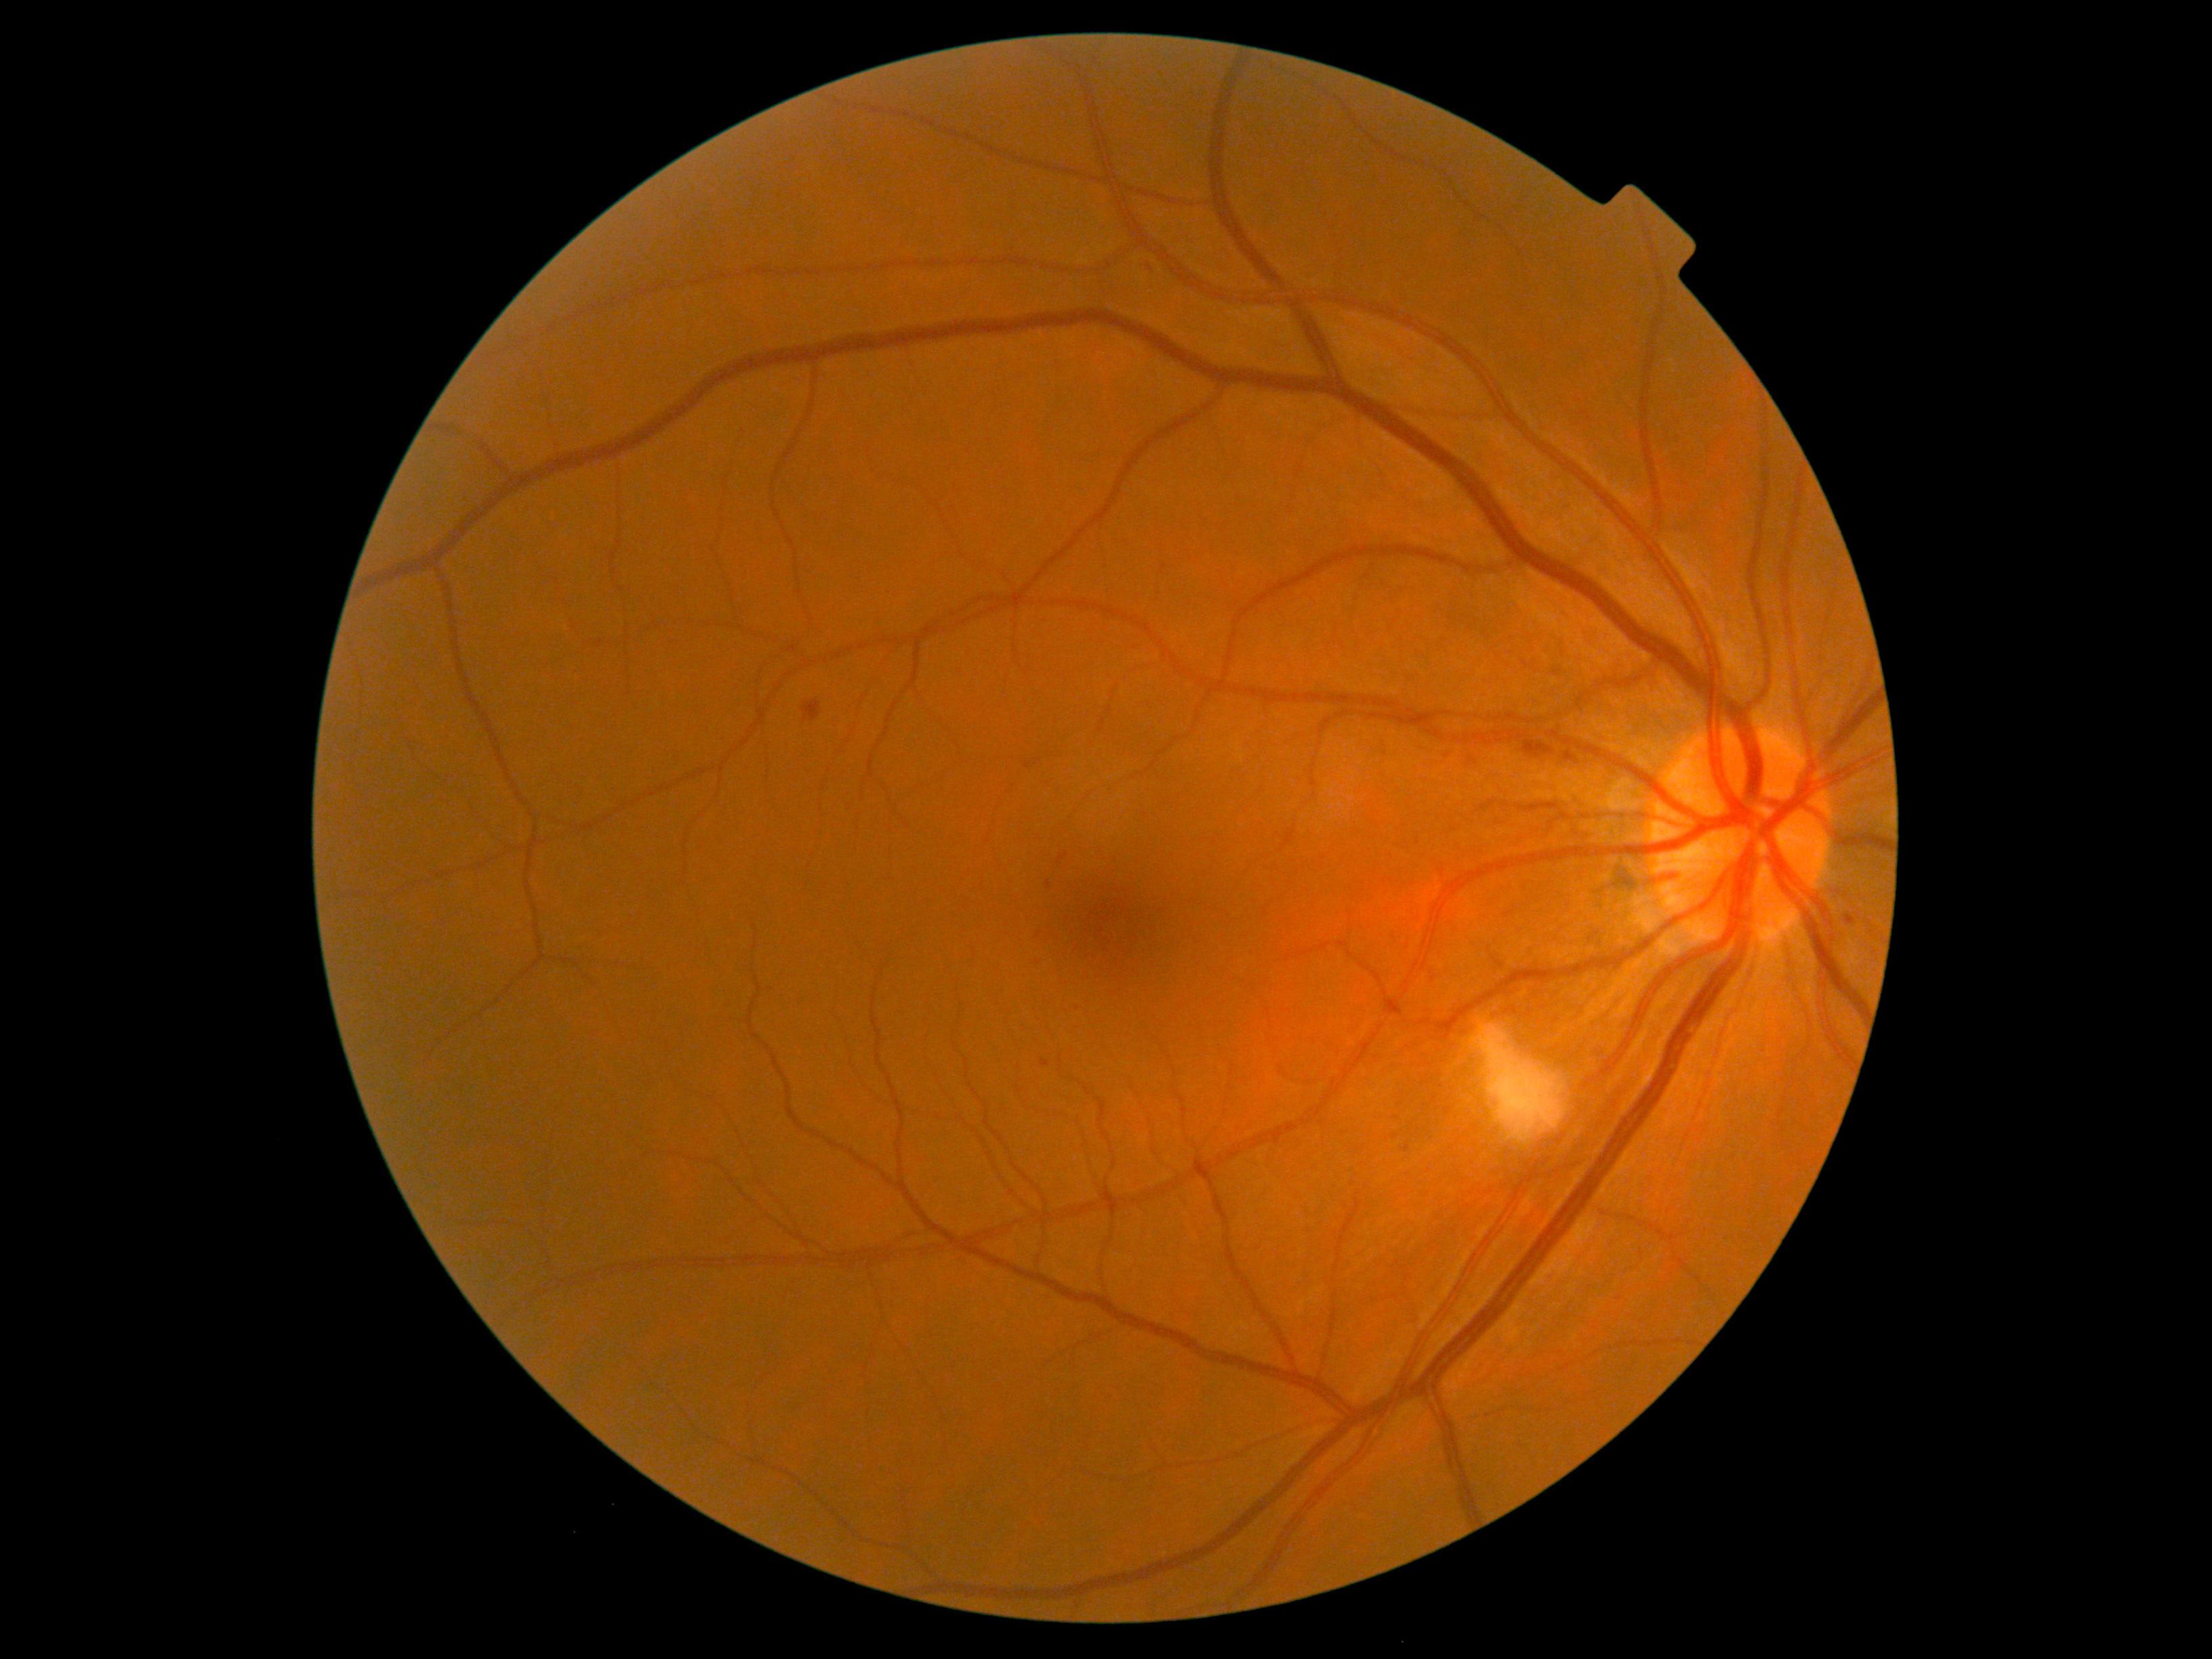
DR grade is 2 (moderate NPDR).